NIDEK AFC-230. 848x848. No pharmacologic dilation. Posterior pole photograph. FOV: 45 degrees: 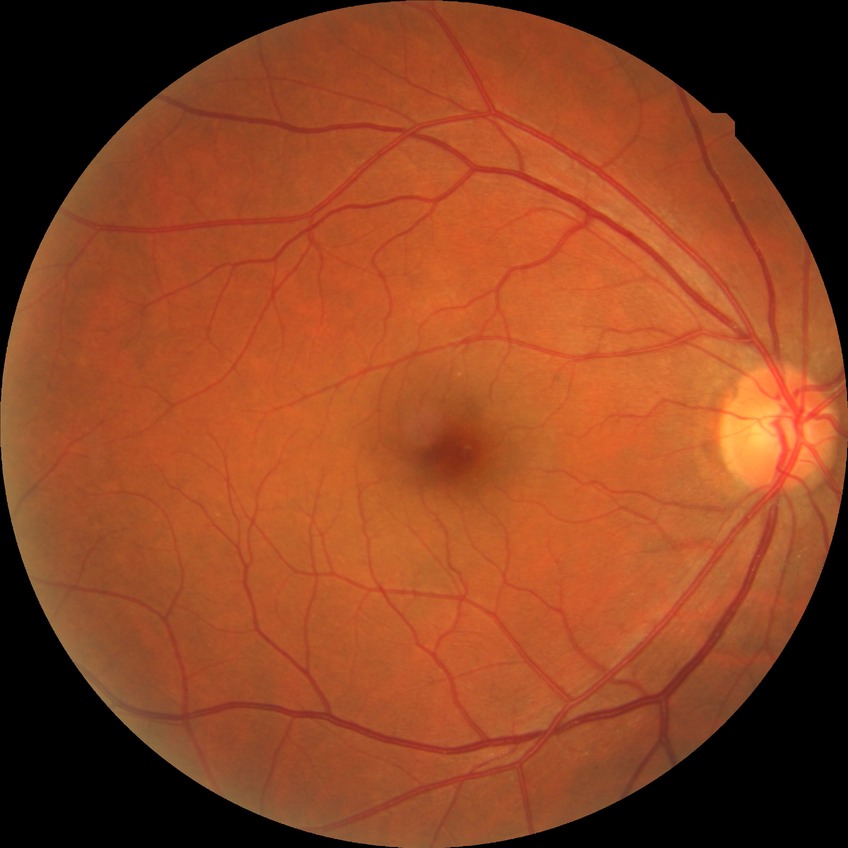

Diabetic retinopathy (DR) is NDR (no diabetic retinopathy).